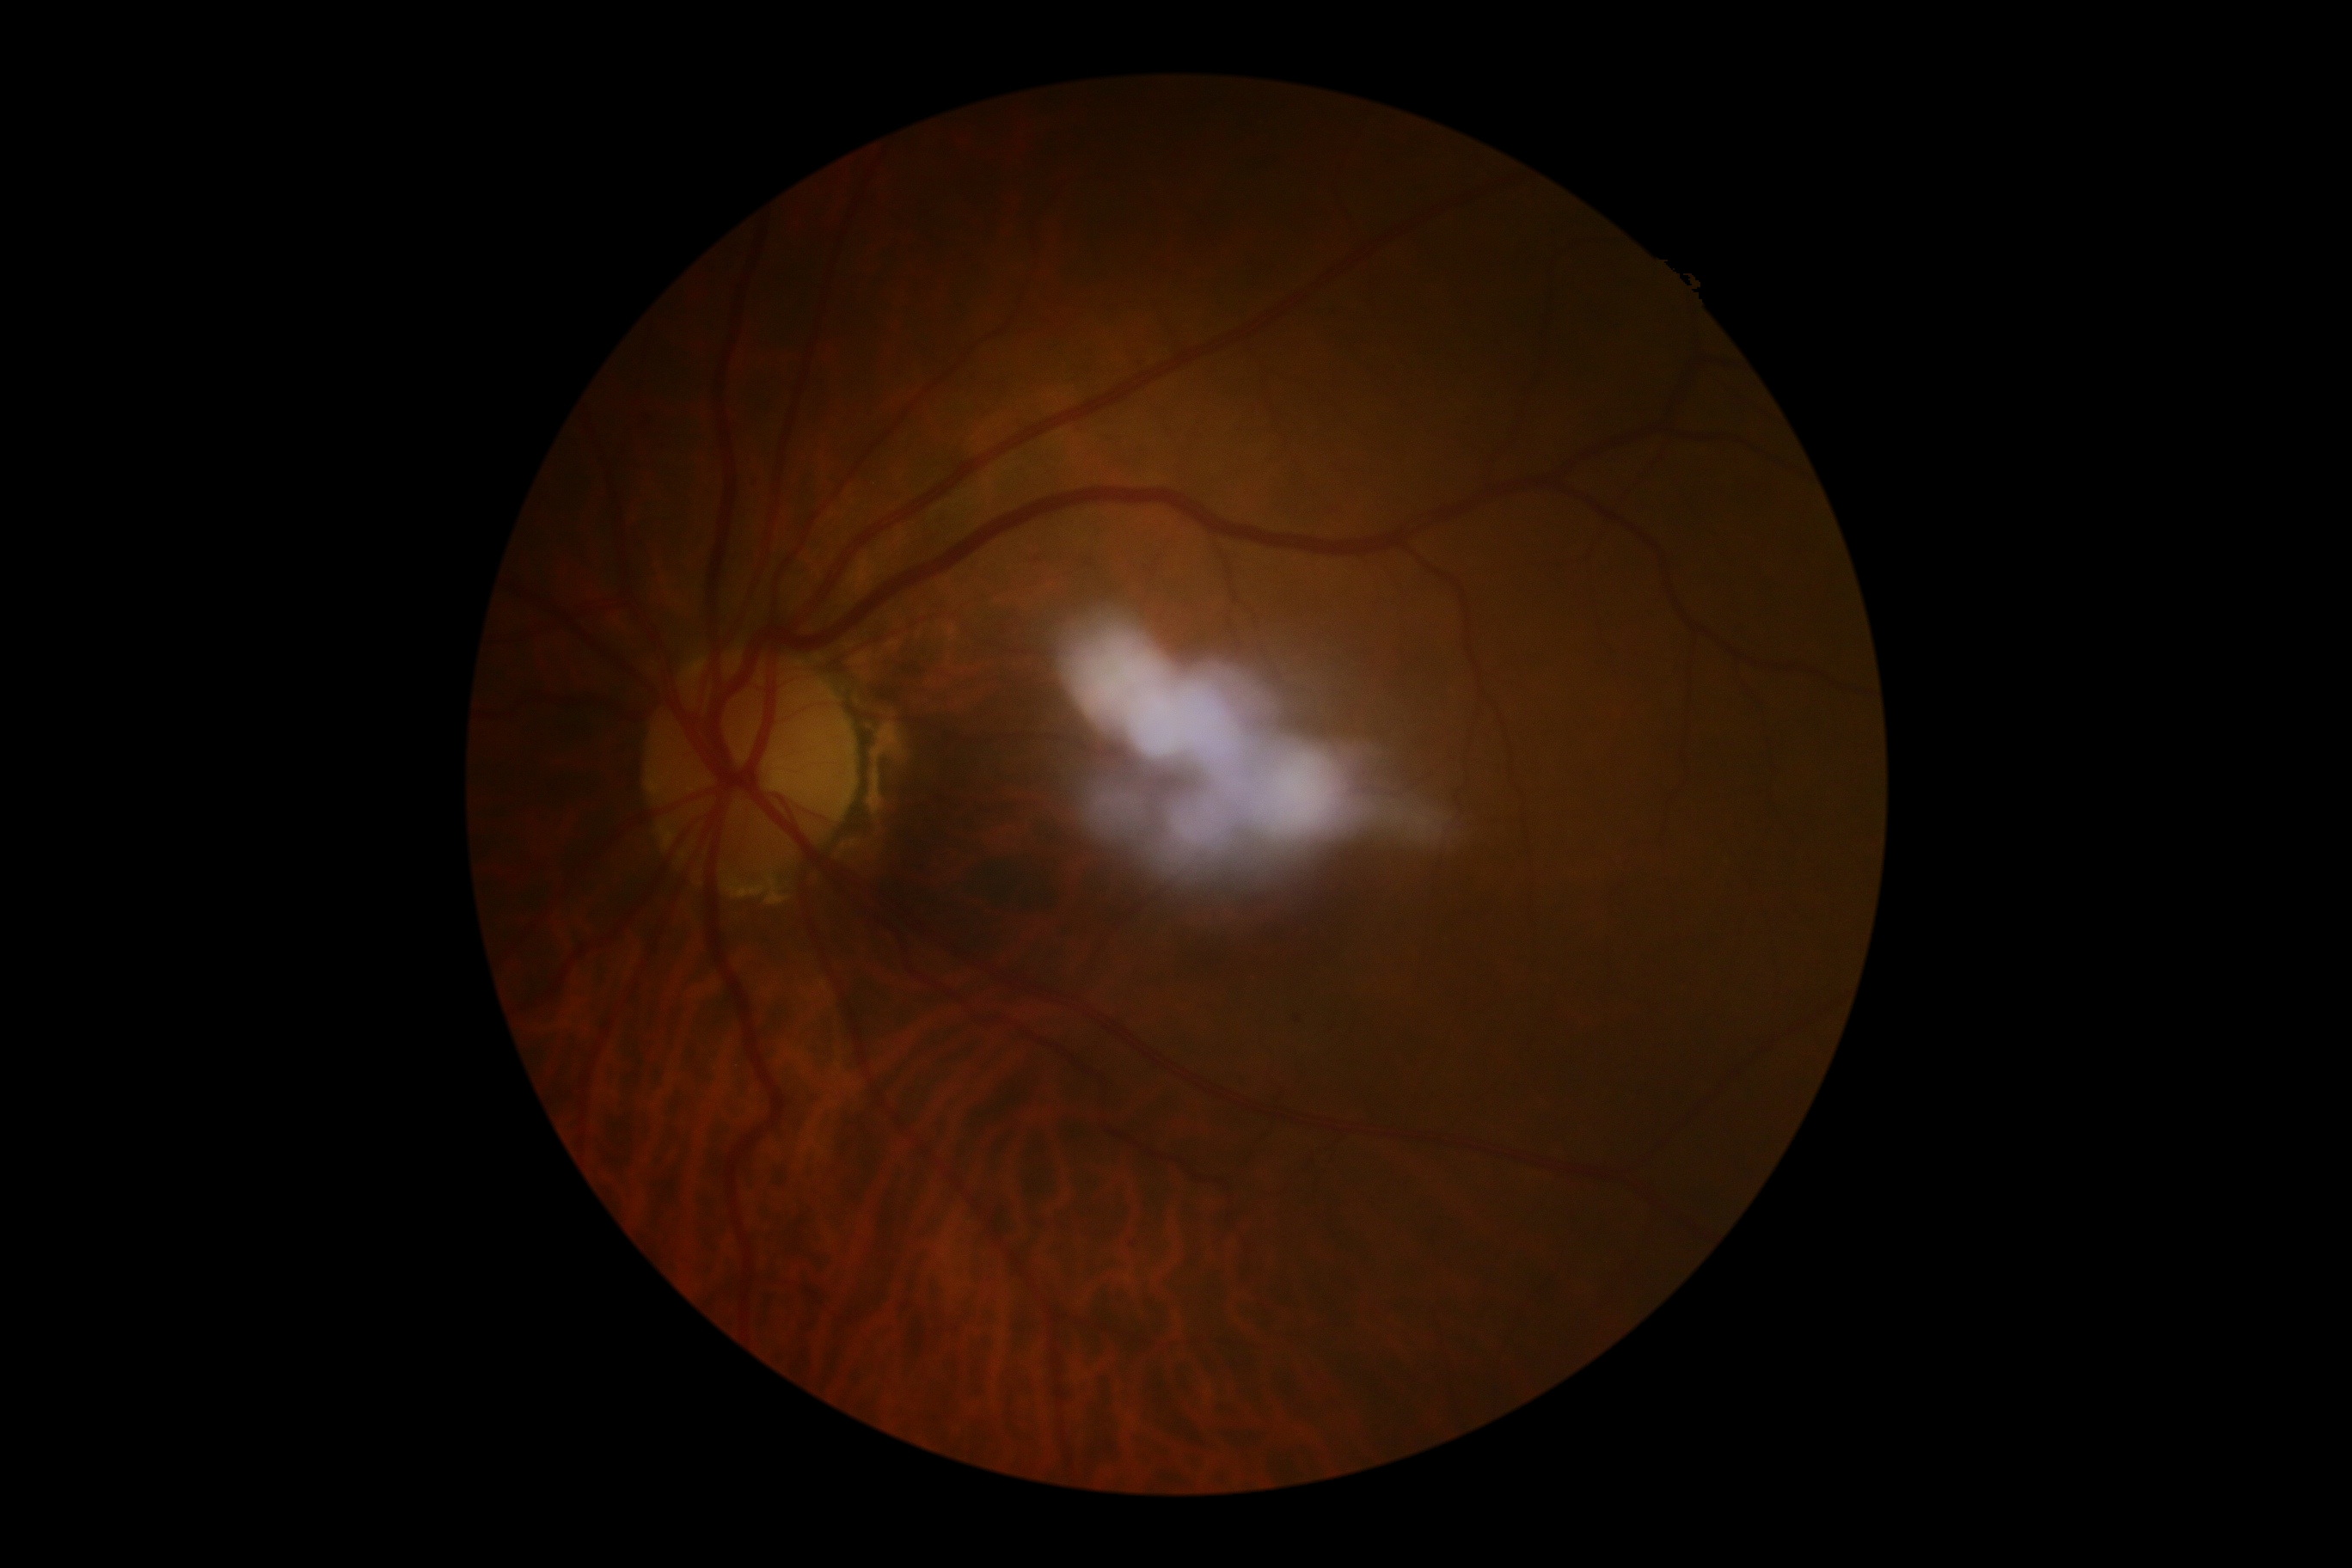

DR severity is grade 1 — presence of microaneurysms only.